Wide-field contact fundus photograph of an infant.
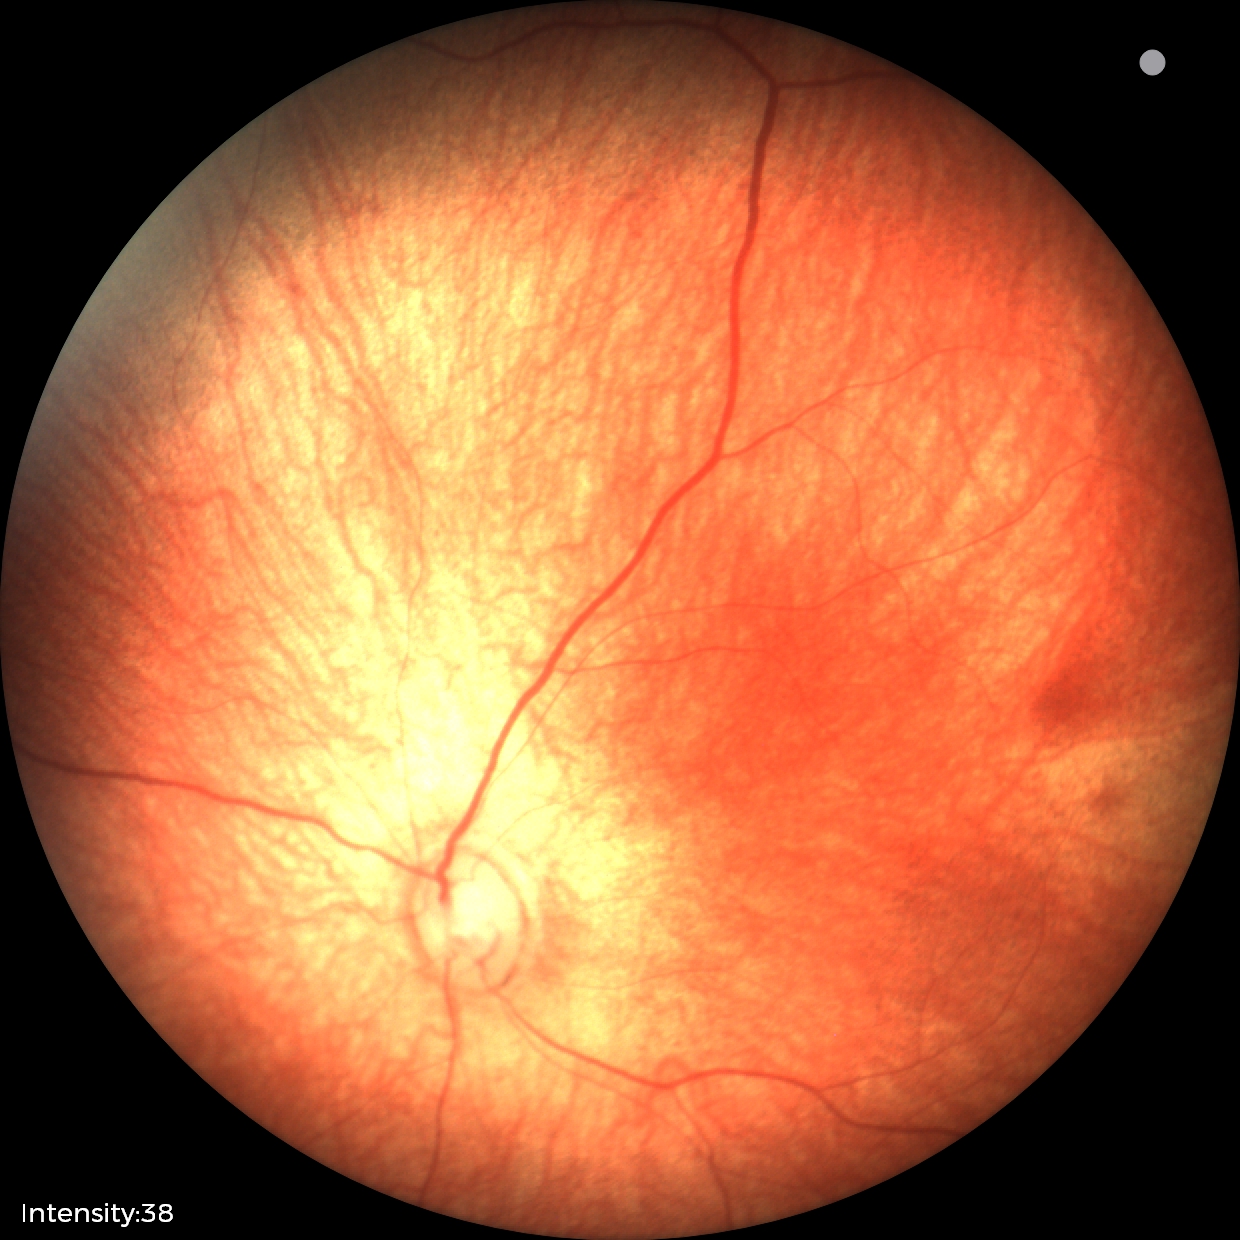 Q: What is the diagnosis from this examination?
A: physiological finding